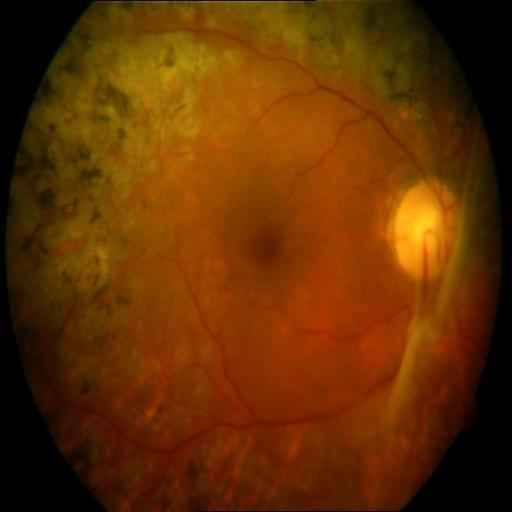

Abnormalities:
- laser scars